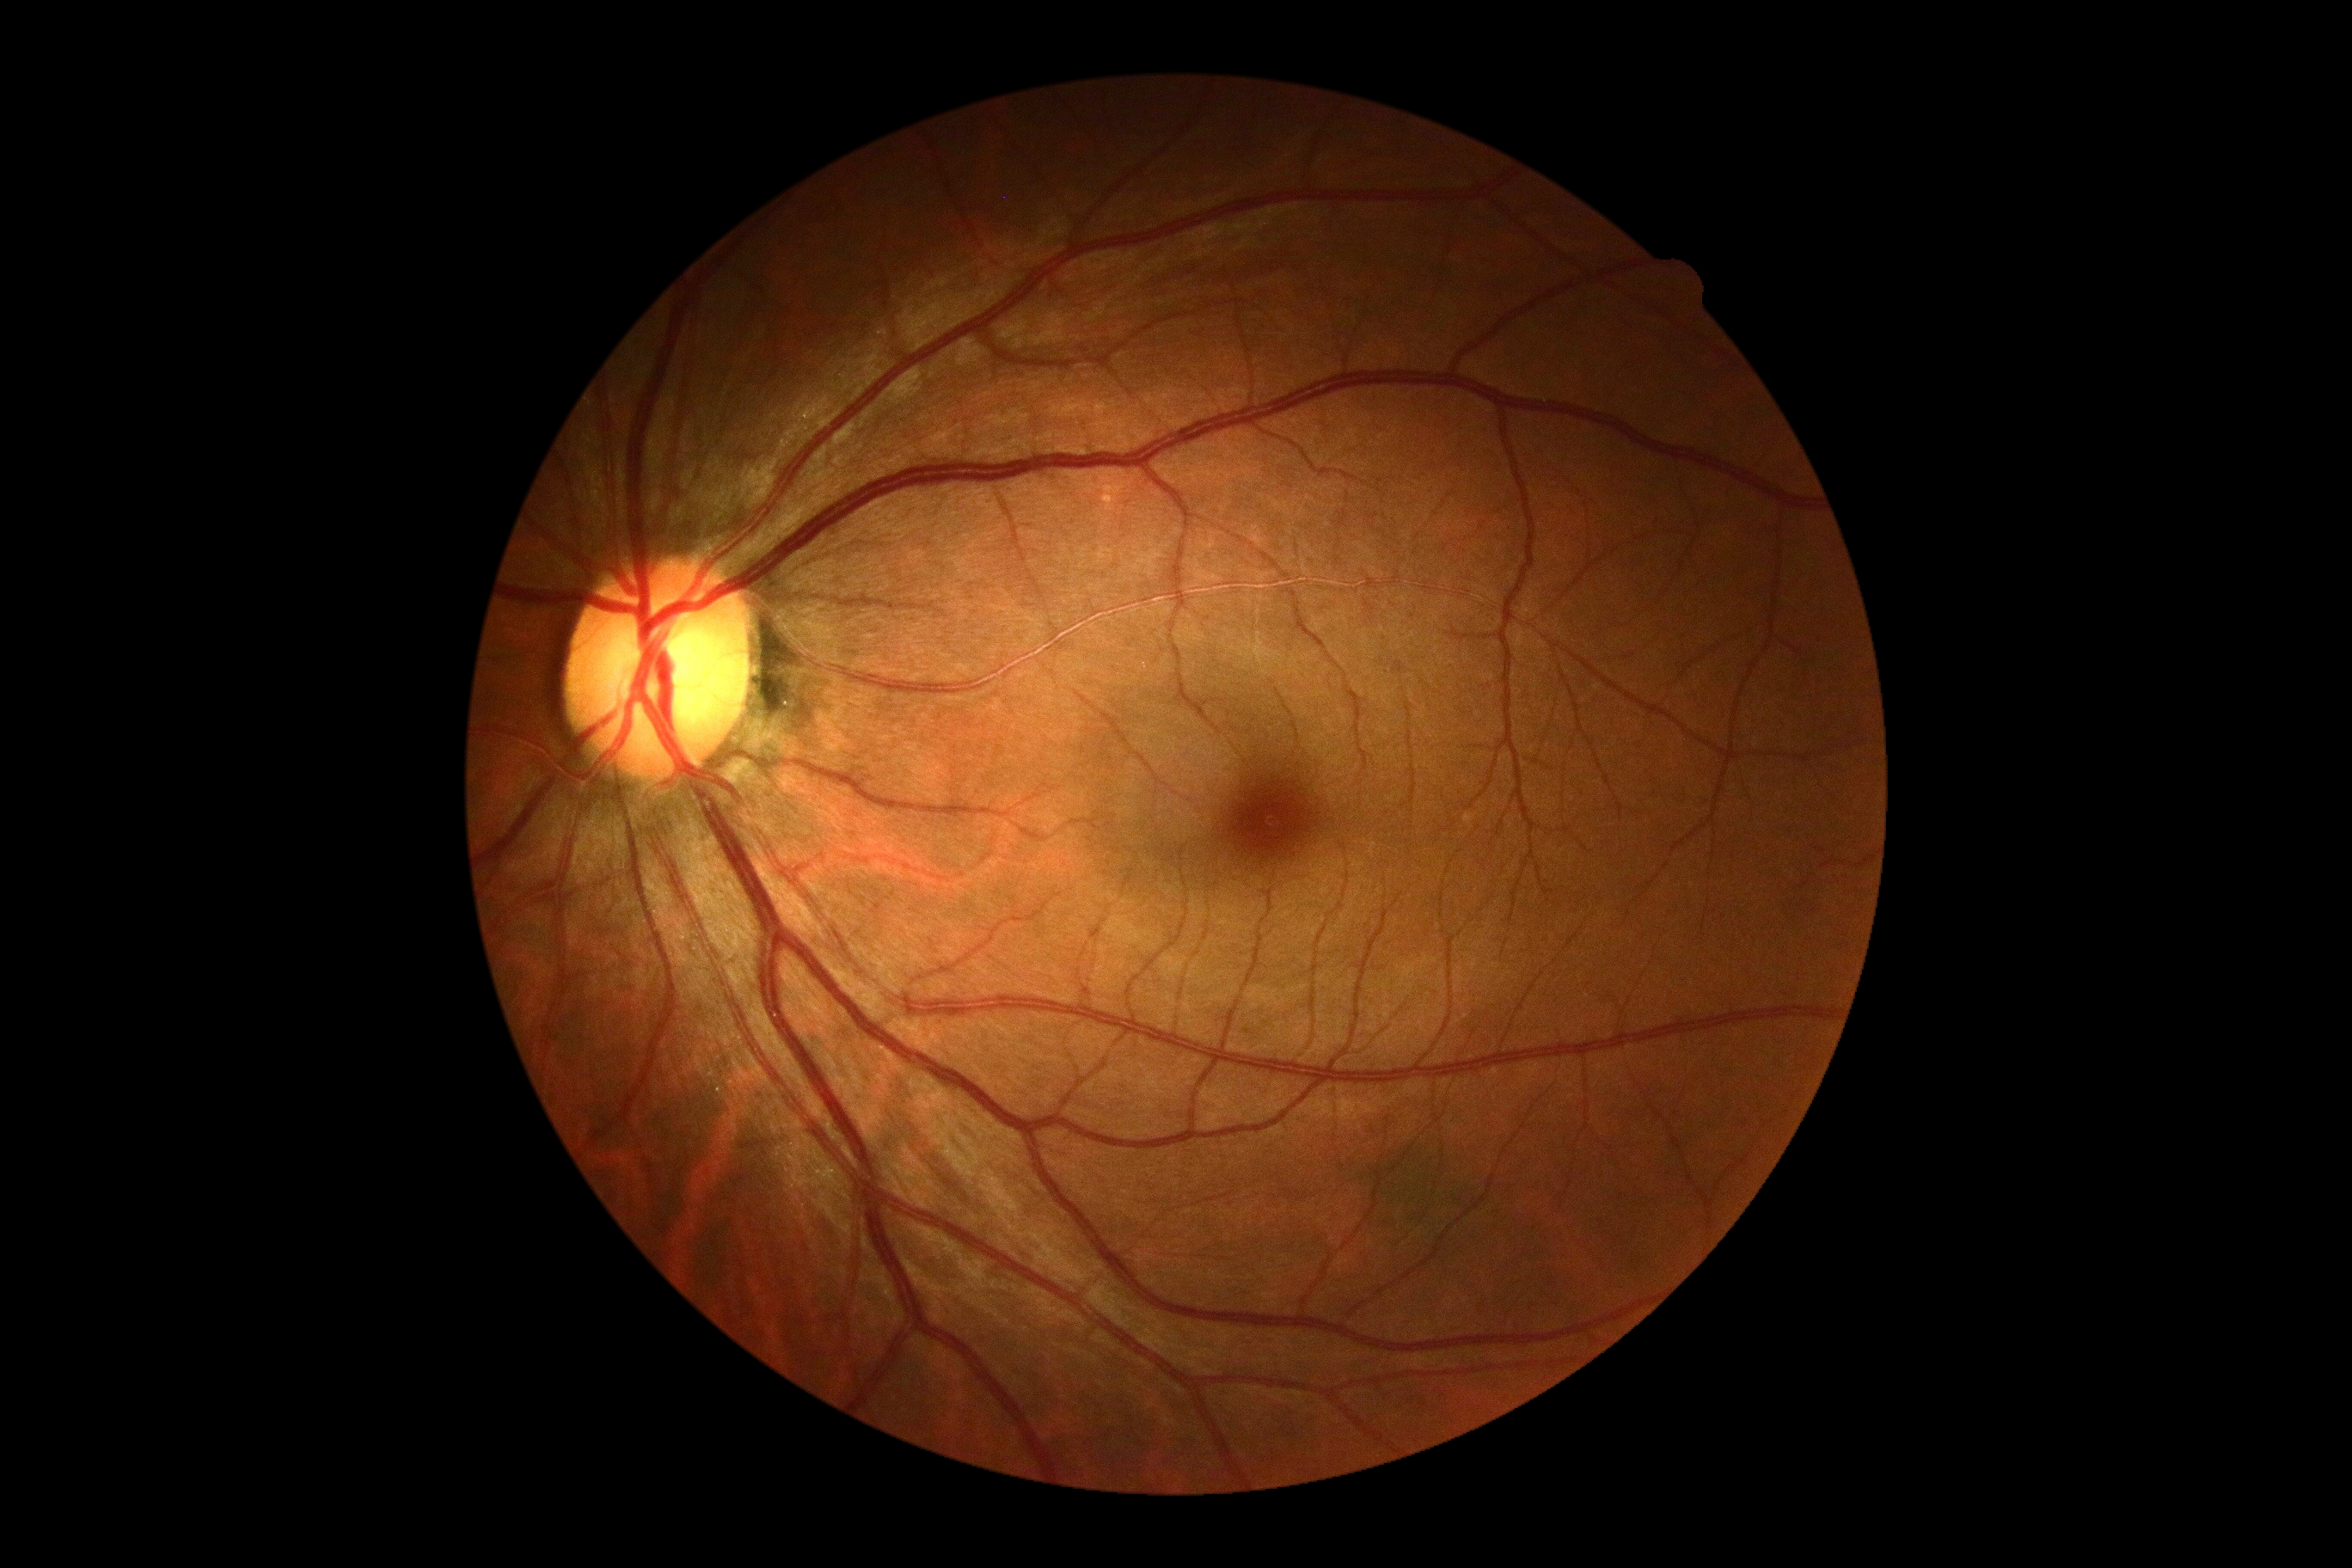 {"dr_grade": "grade 0", "dr_impression": "no apparent DR"}